848x848px; modified Davis grading; no pharmacologic dilation — 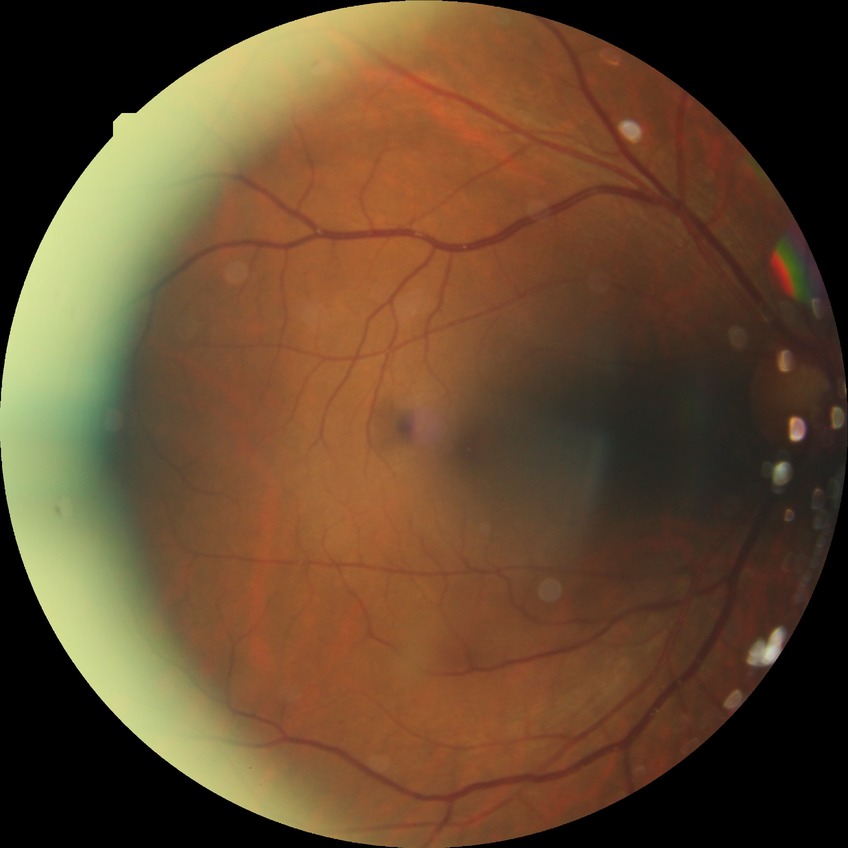

Diabetic retinopathy (DR): NDR (no diabetic retinopathy).